Color fundus image; image size 2089x1764 — 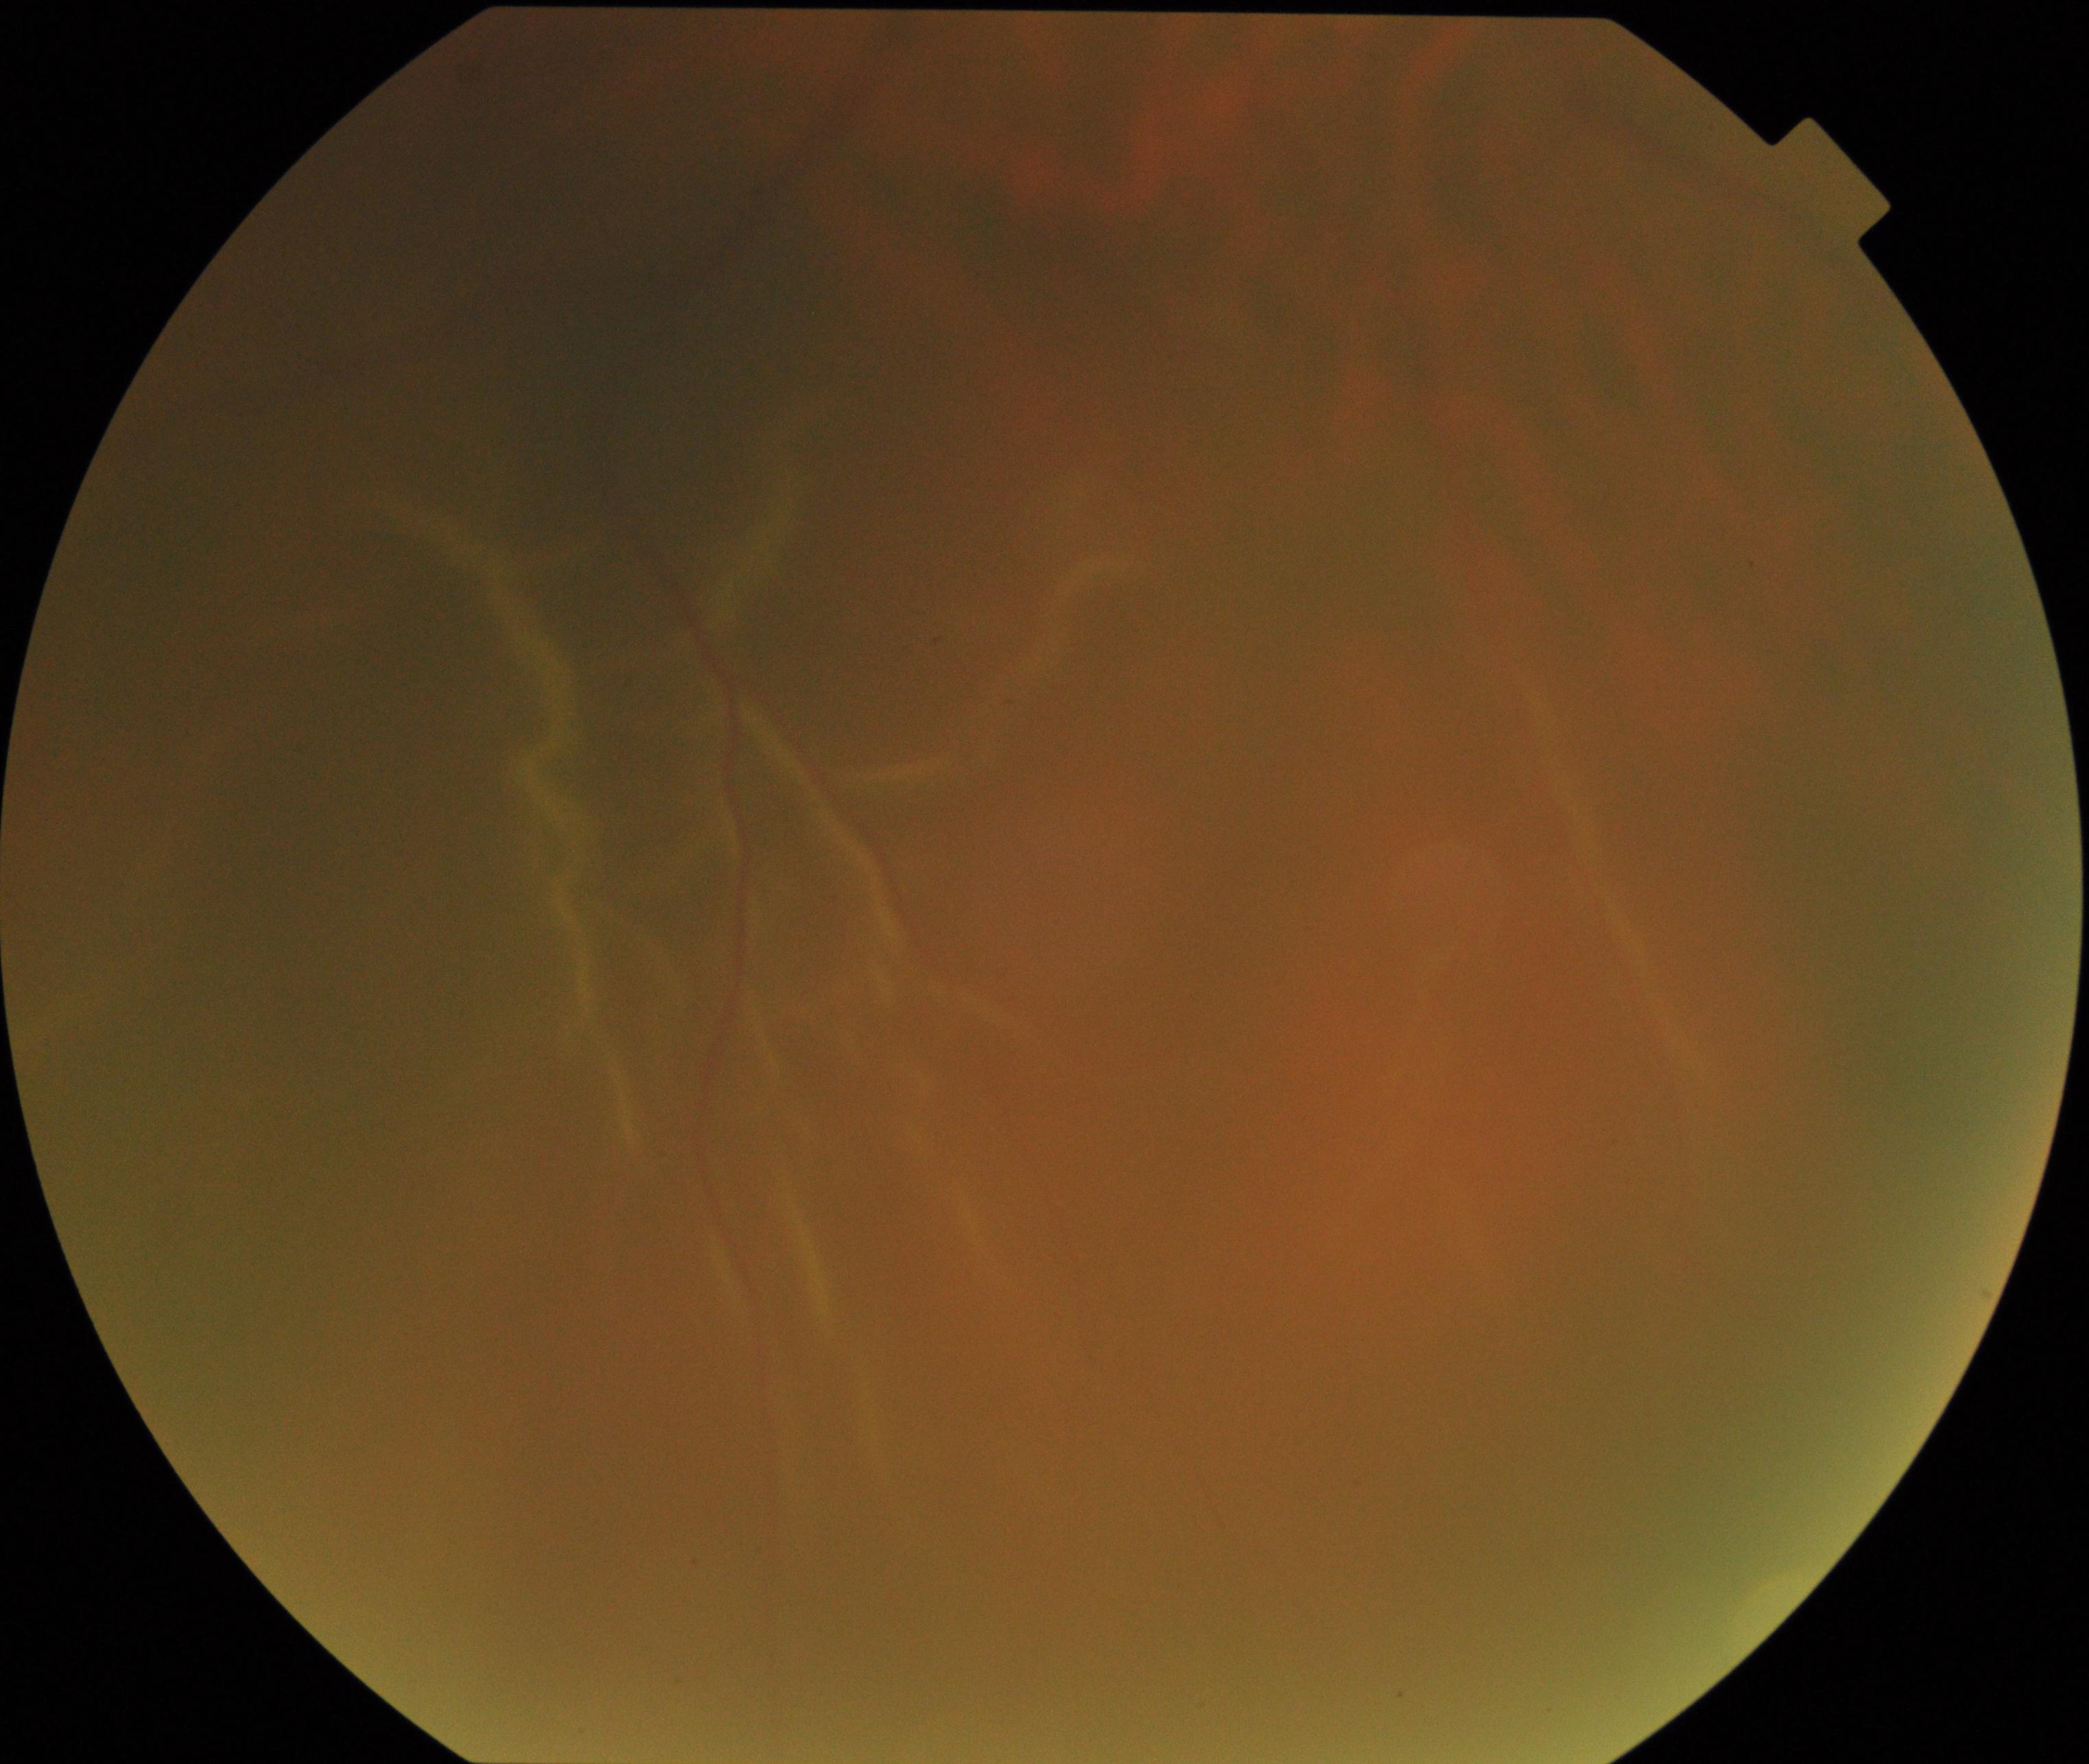
Findings: rhegmatogenous retinal detachment.